Clarity RetCam 3, 130° FOV. Infant wide-field fundus photograph: 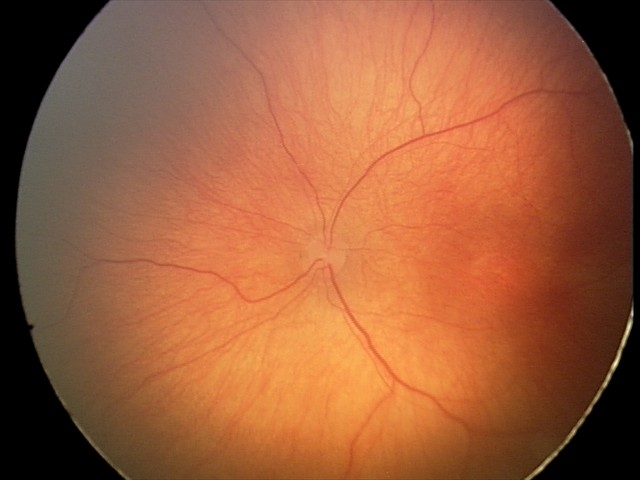 Q: What was the screening finding?
A: retinopathy of prematurity stage 2